Posterior pole color fundus photograph, image size 848x848: 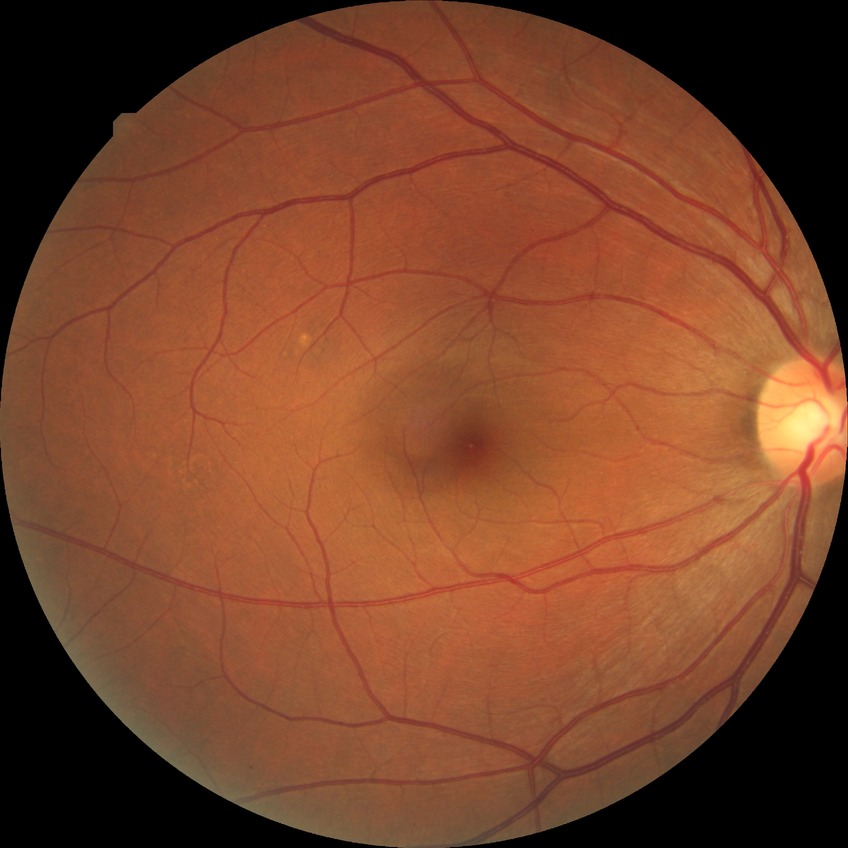

Modified Davis classification is no diabetic retinopathy.